Color fundus photograph. 1504x1000: 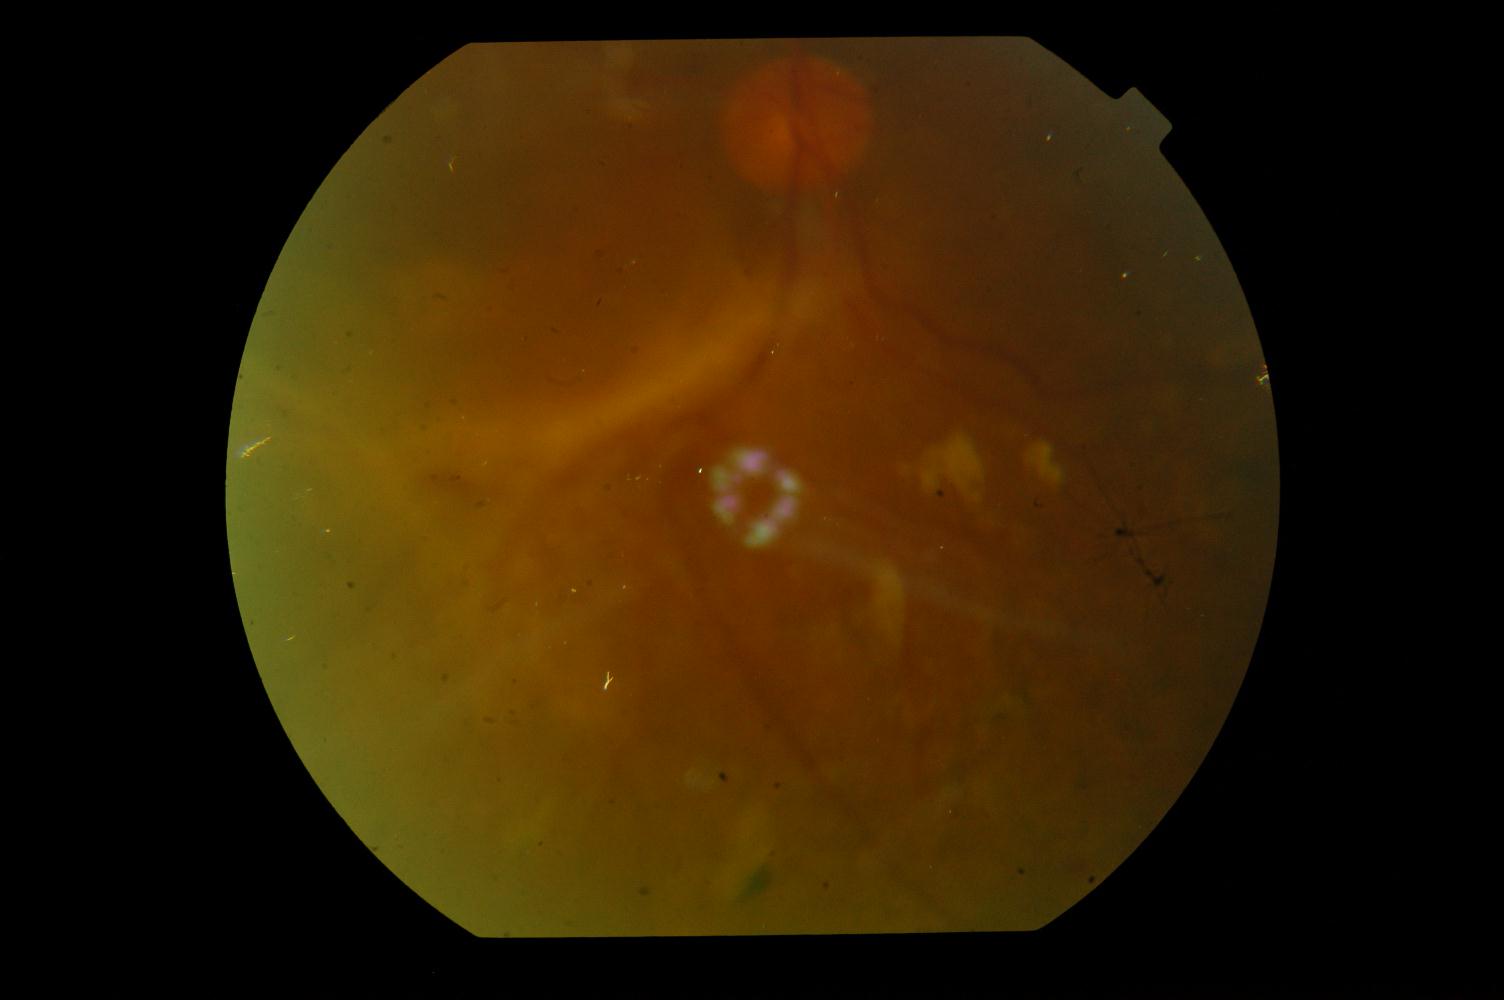

Demonstrates diabetic retinopathy.